45-degree field of view. 2352x1568 — 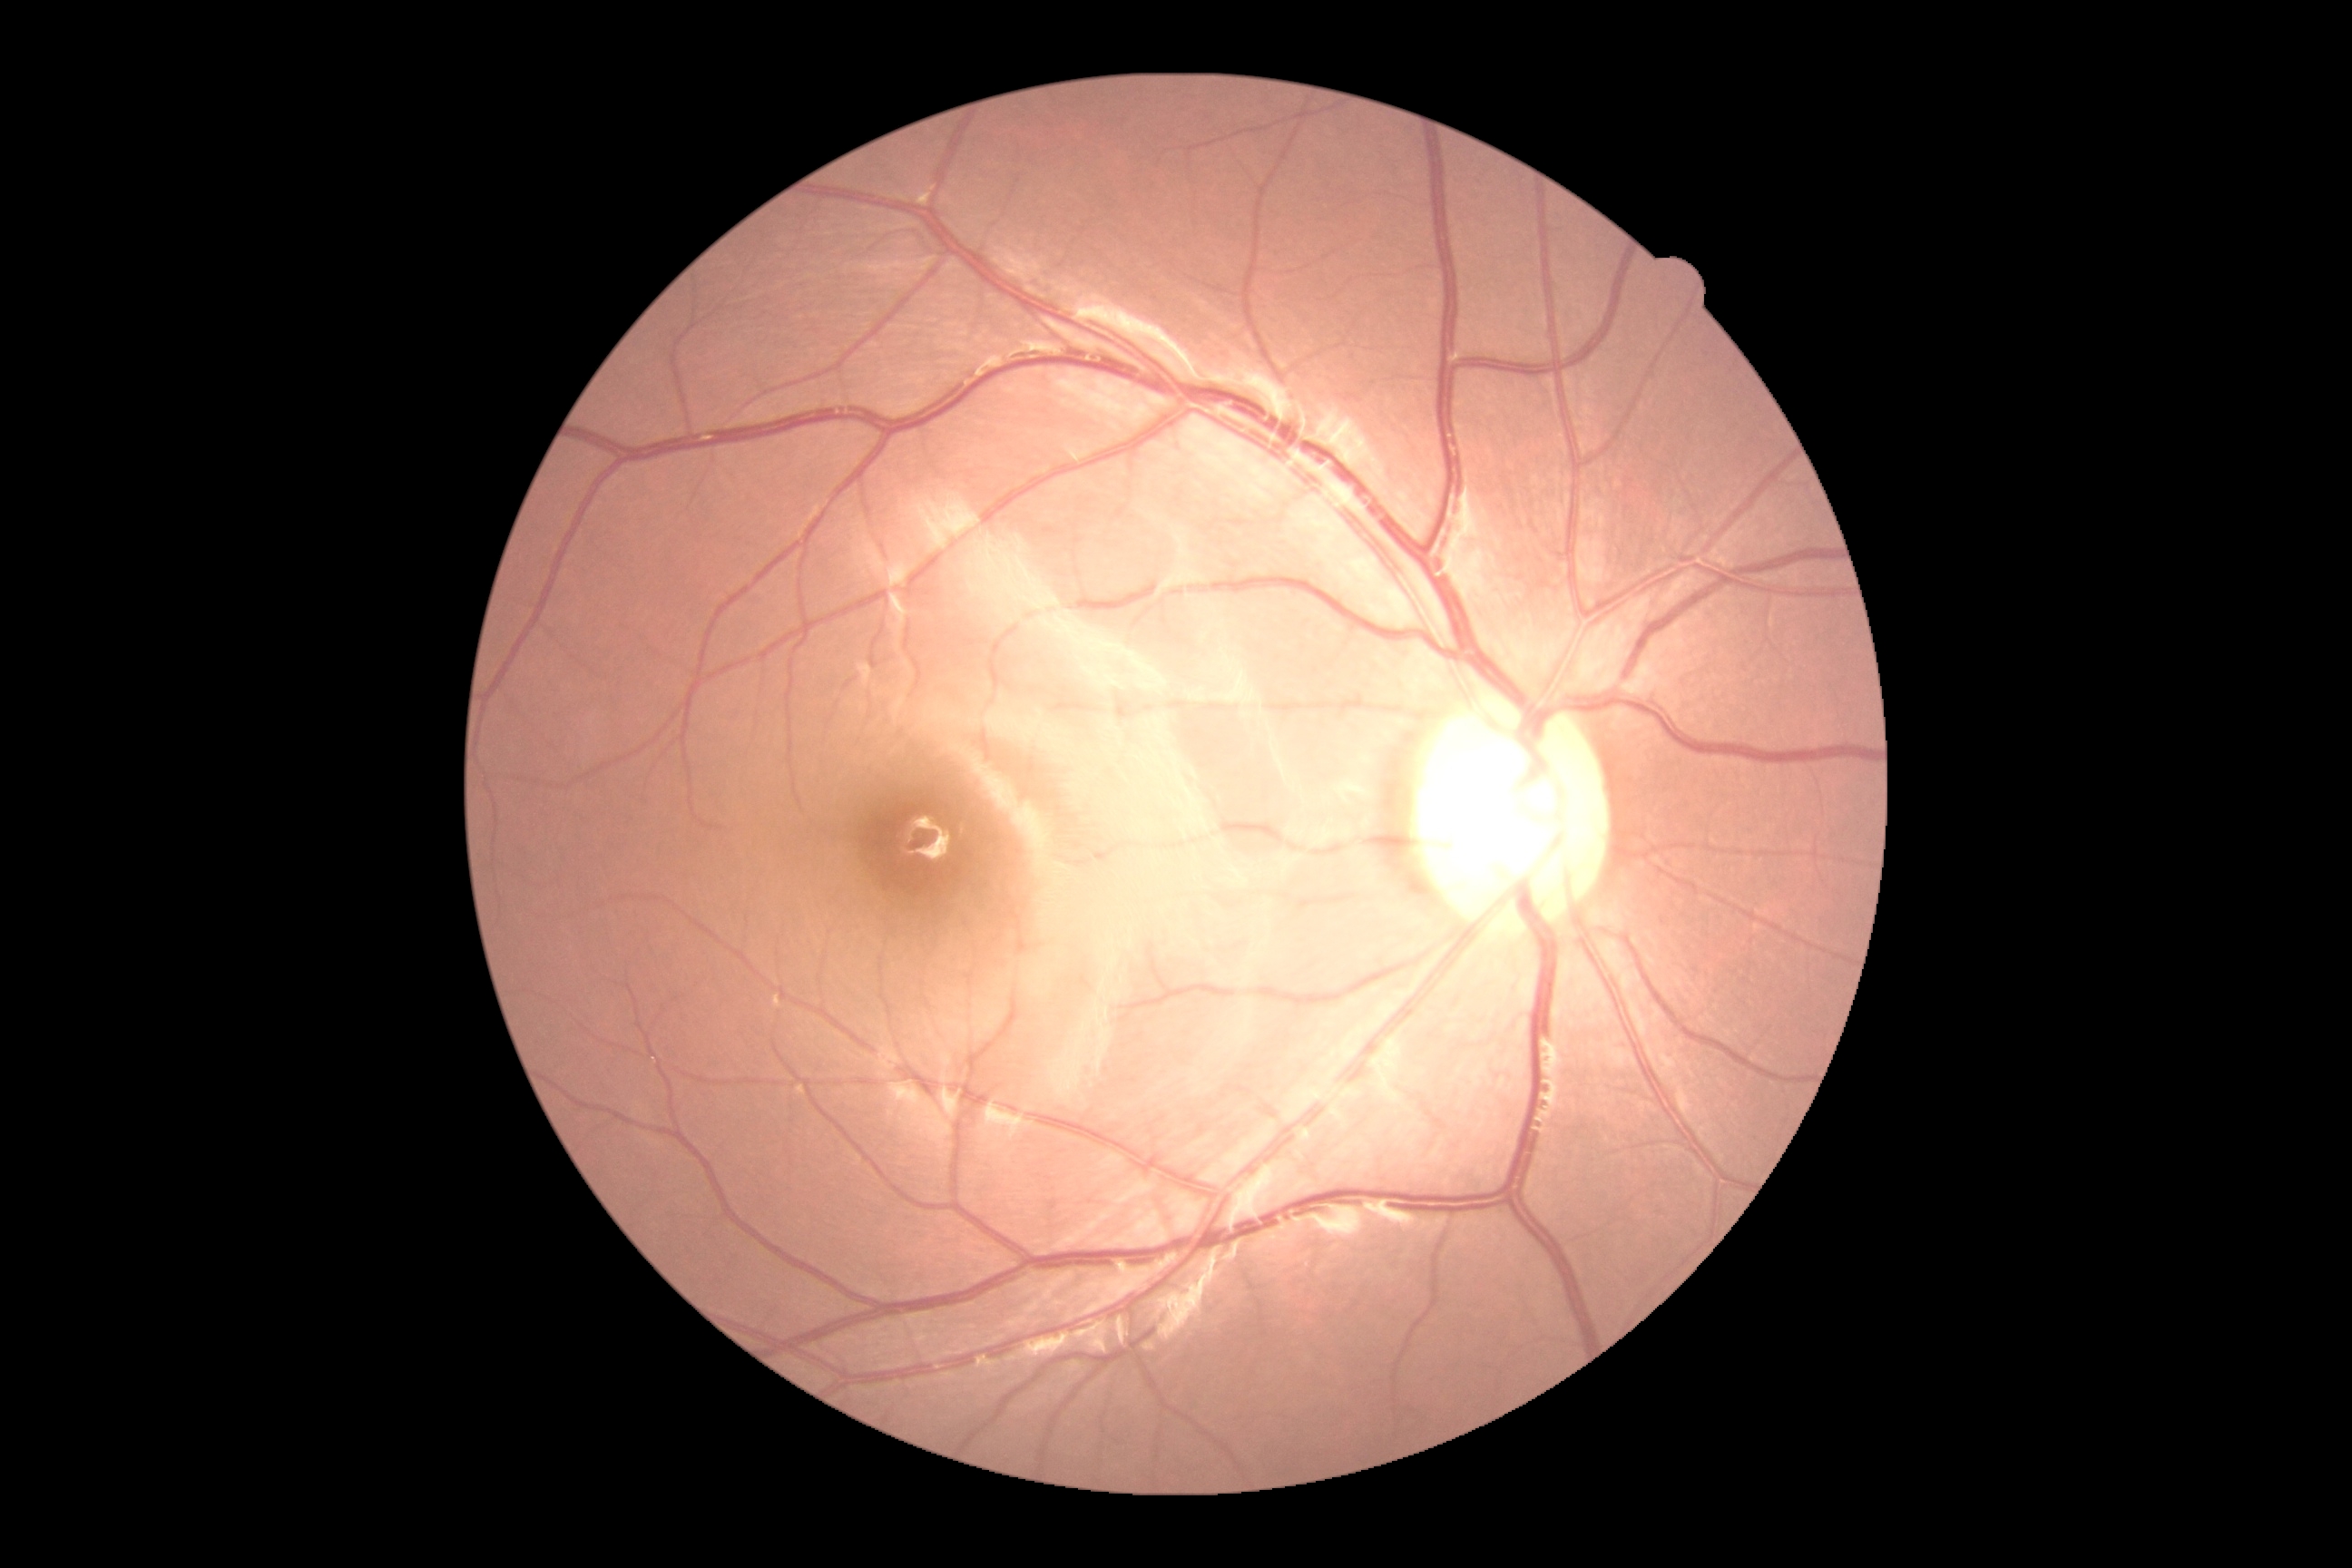
DR grade is no apparent retinopathy (0).
No signs of diabetic retinopathy.